45° FOV, image size 2048x1536 — 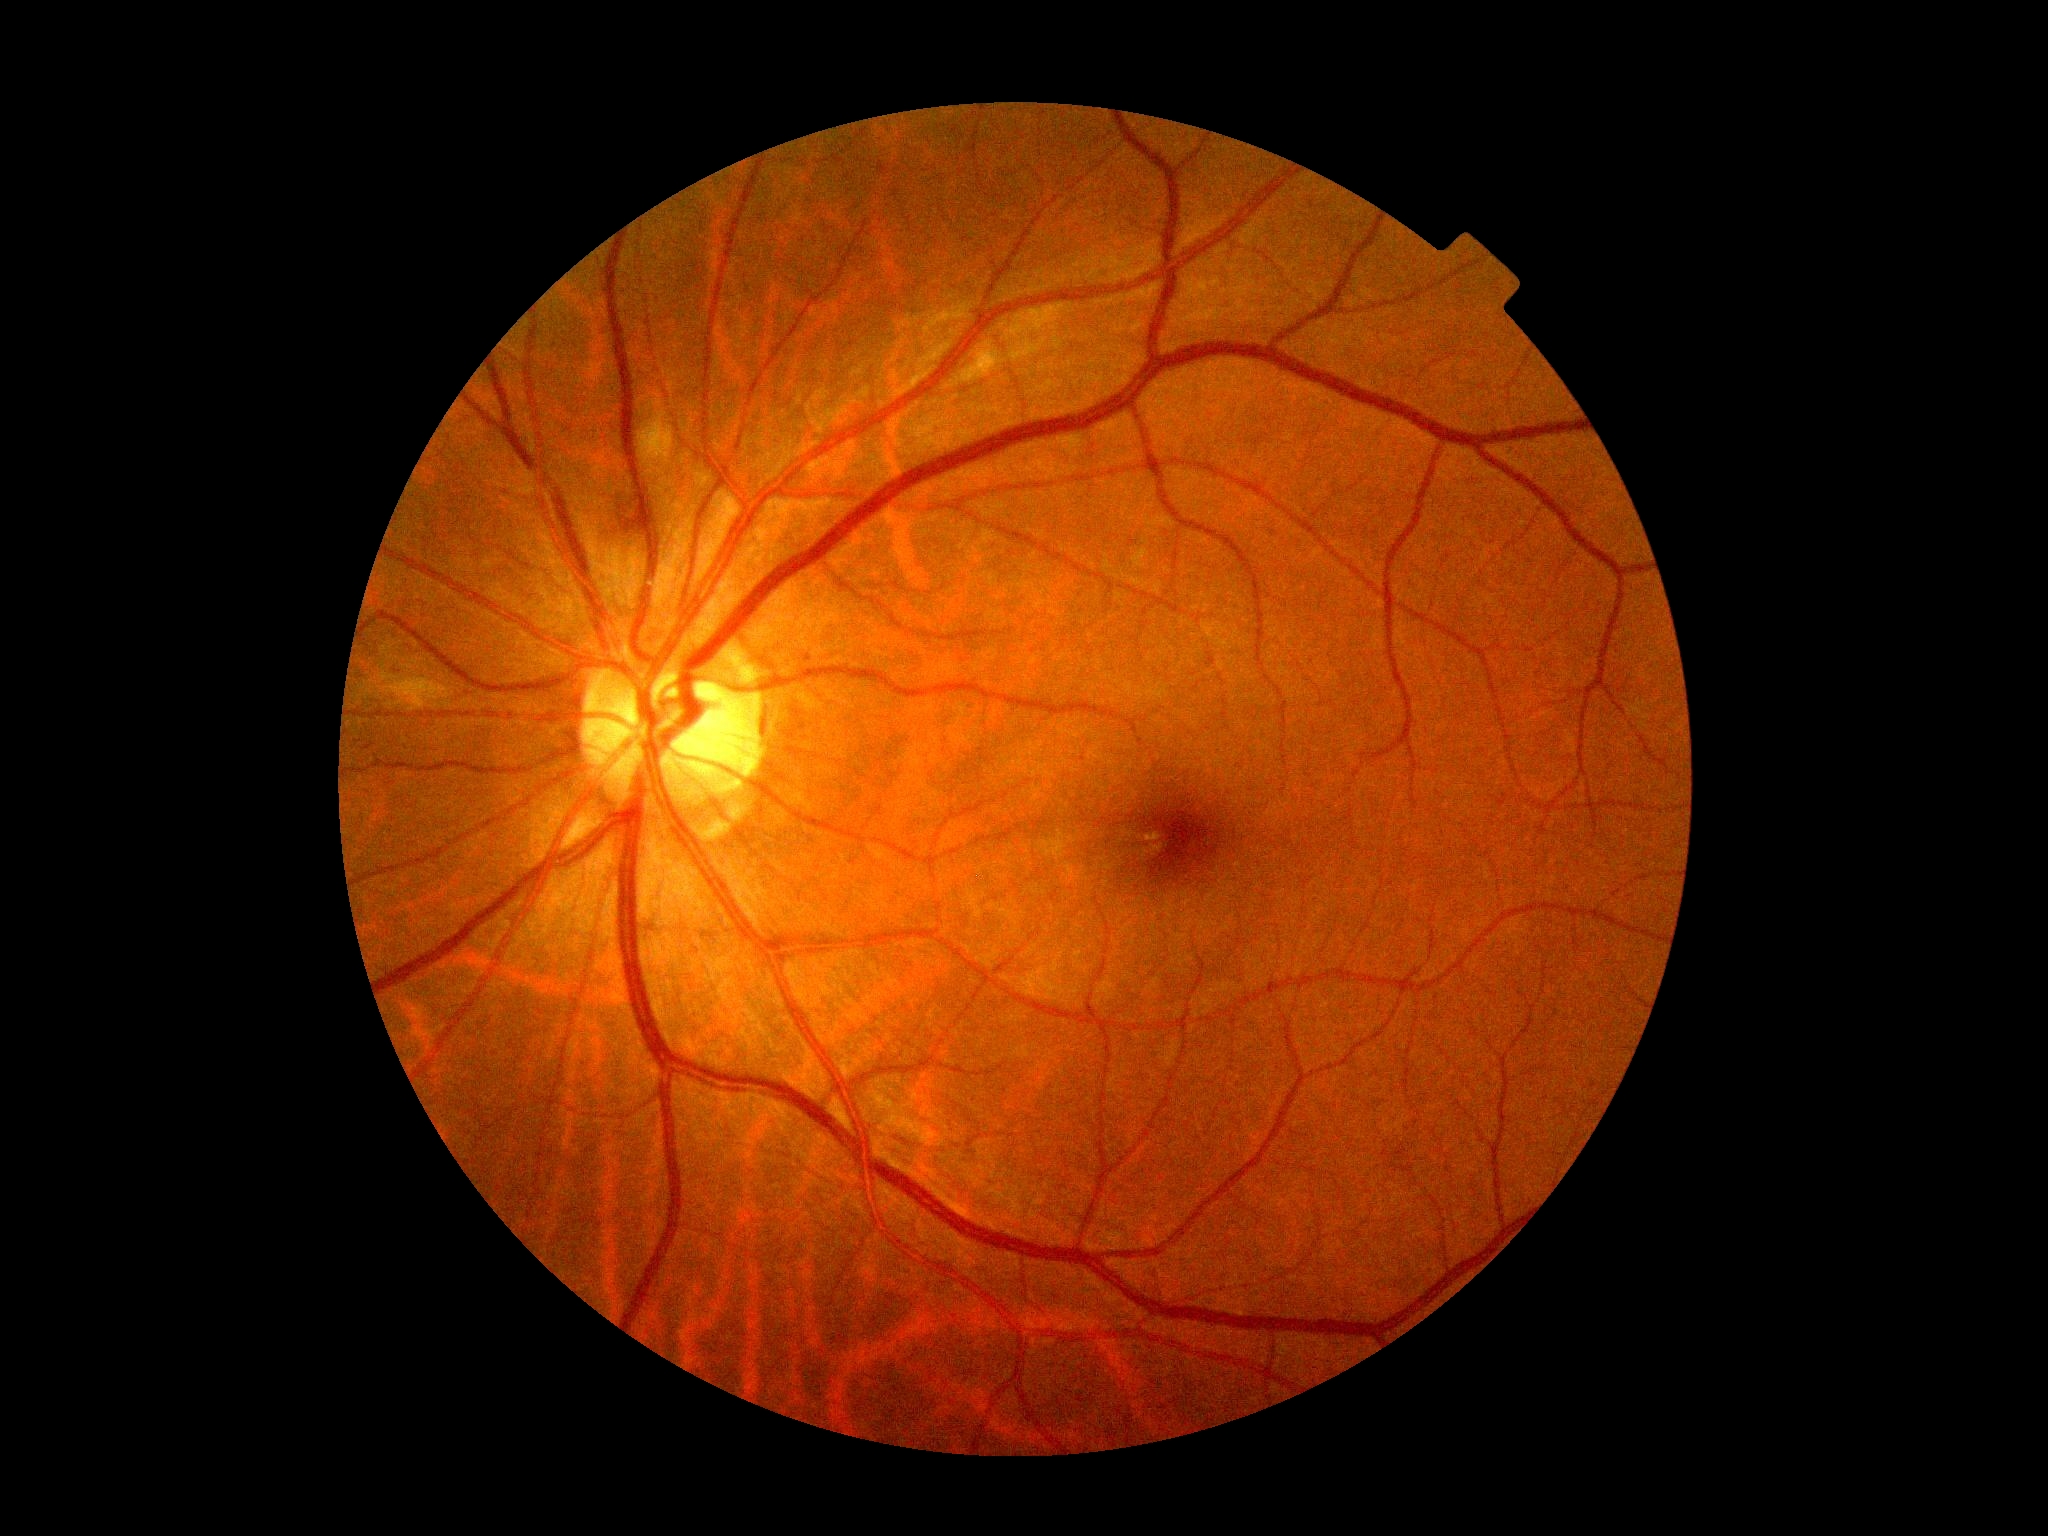

DR stage: grade 2 (moderate NPDR) — more than just microaneurysms but less than severe NPDR.